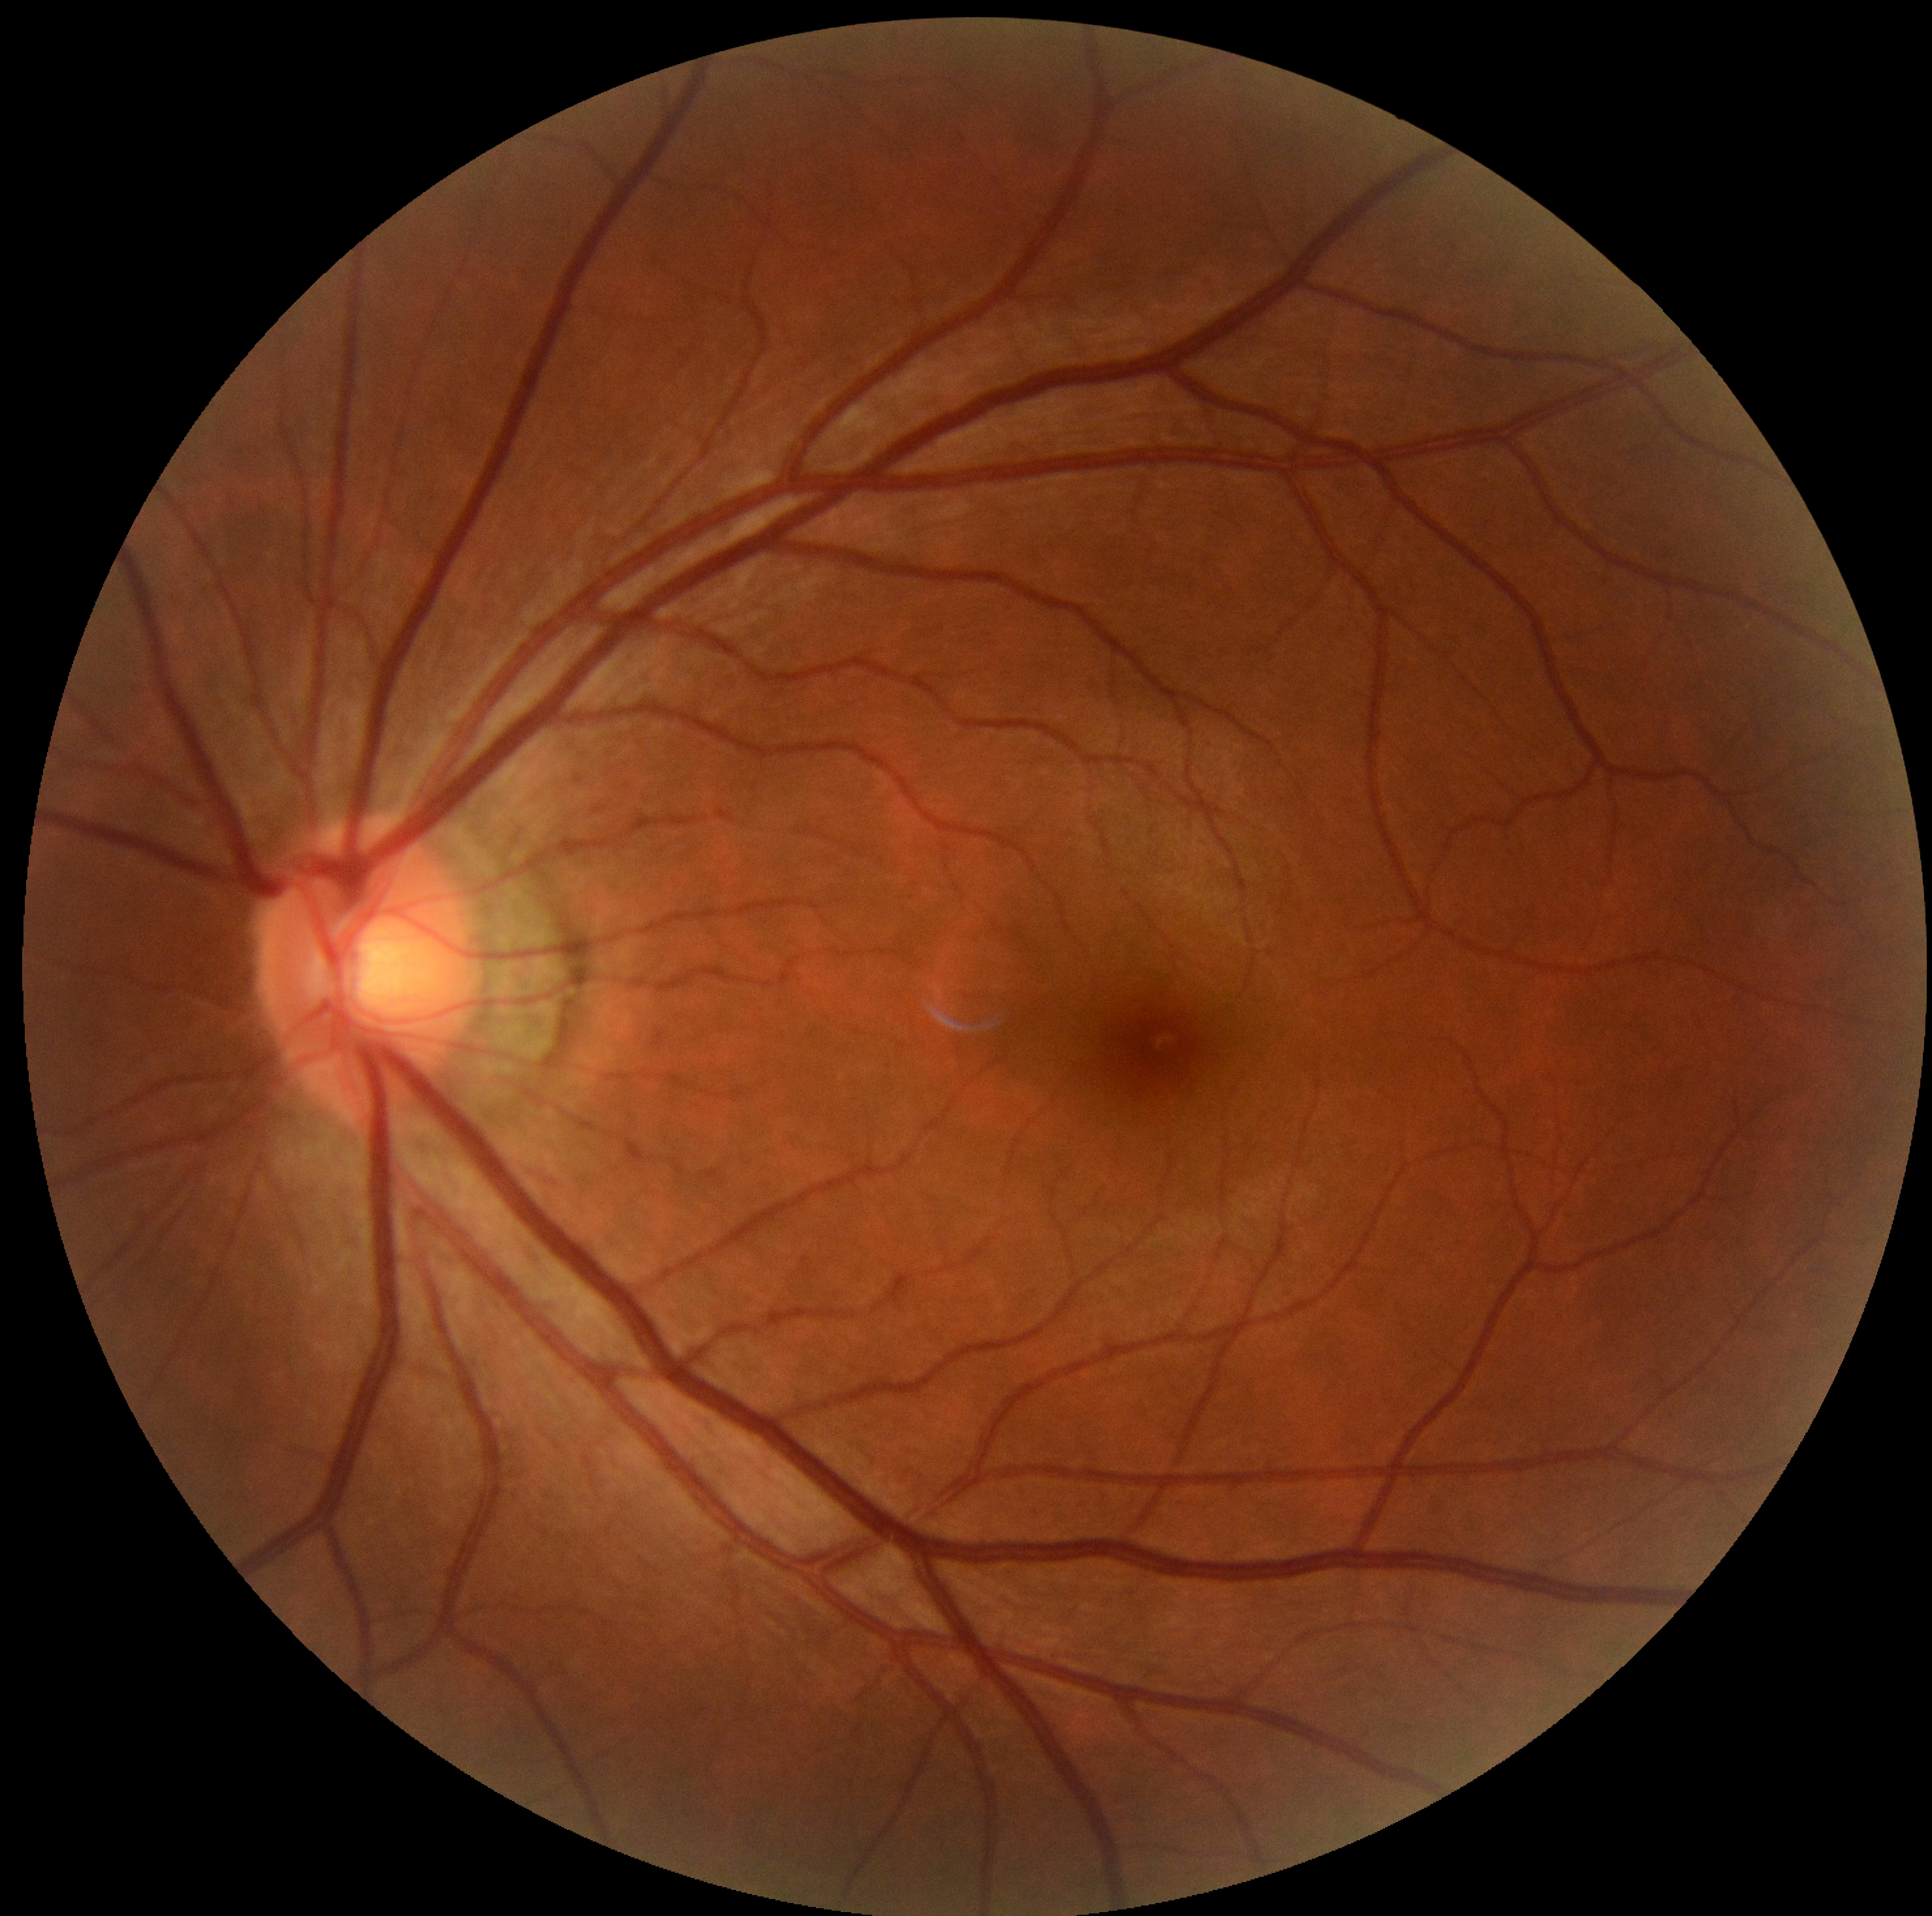
{
  "dr_grade": "grade 0 (no apparent retinopathy)"
}